No pharmacologic dilation.
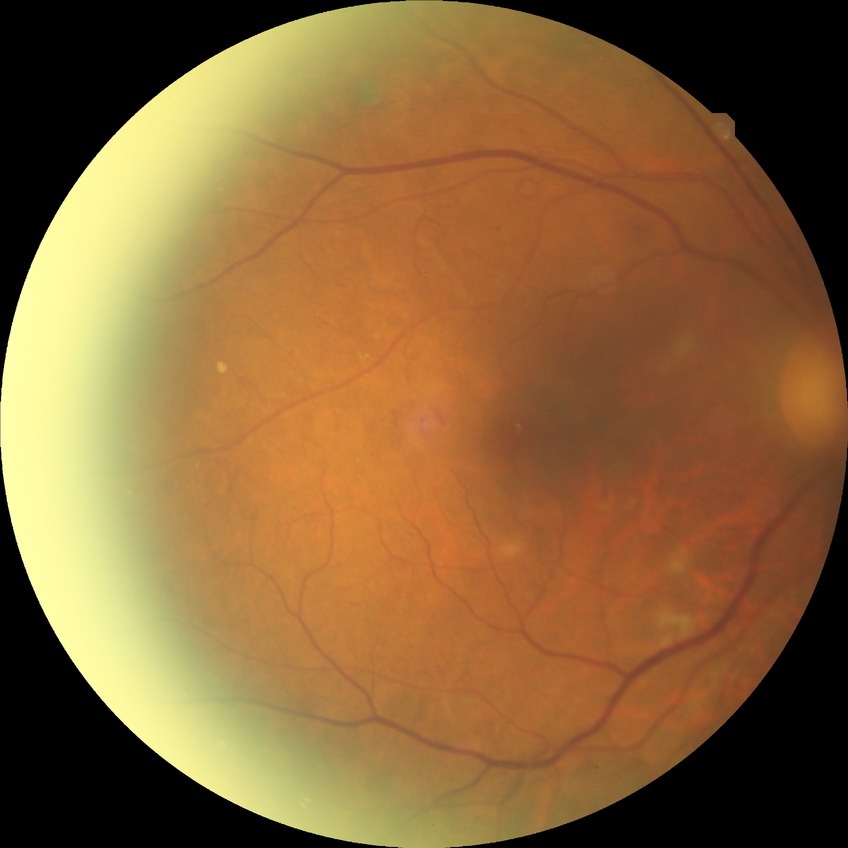 Davis DR grade: PDR.